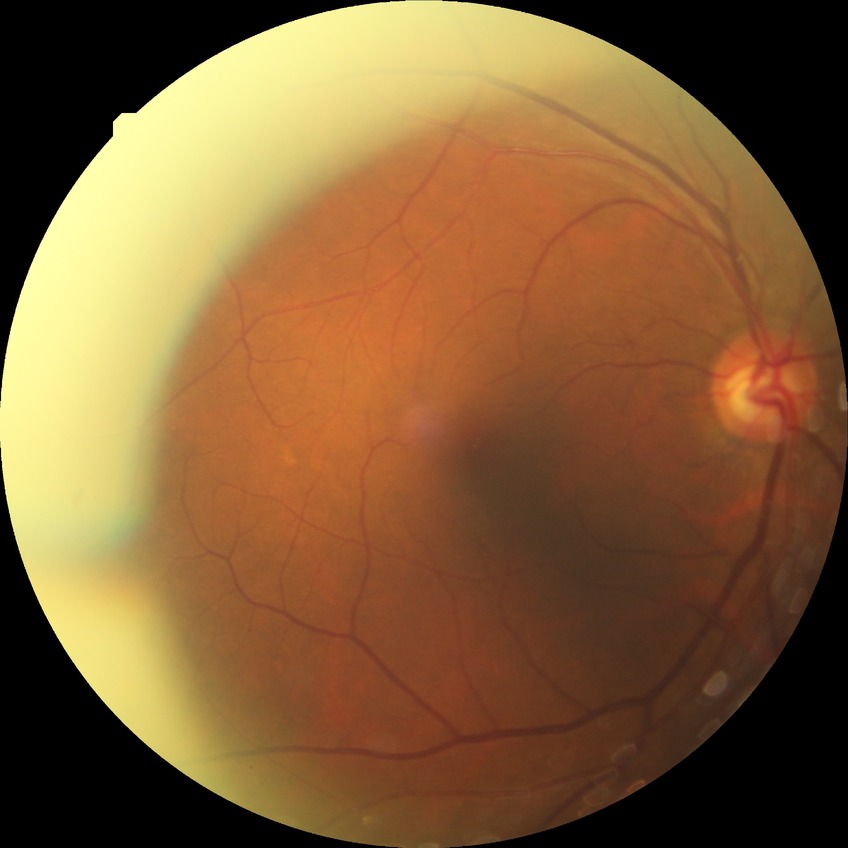
Diabetic retinopathy (DR) is no diabetic retinopathy (NDR).